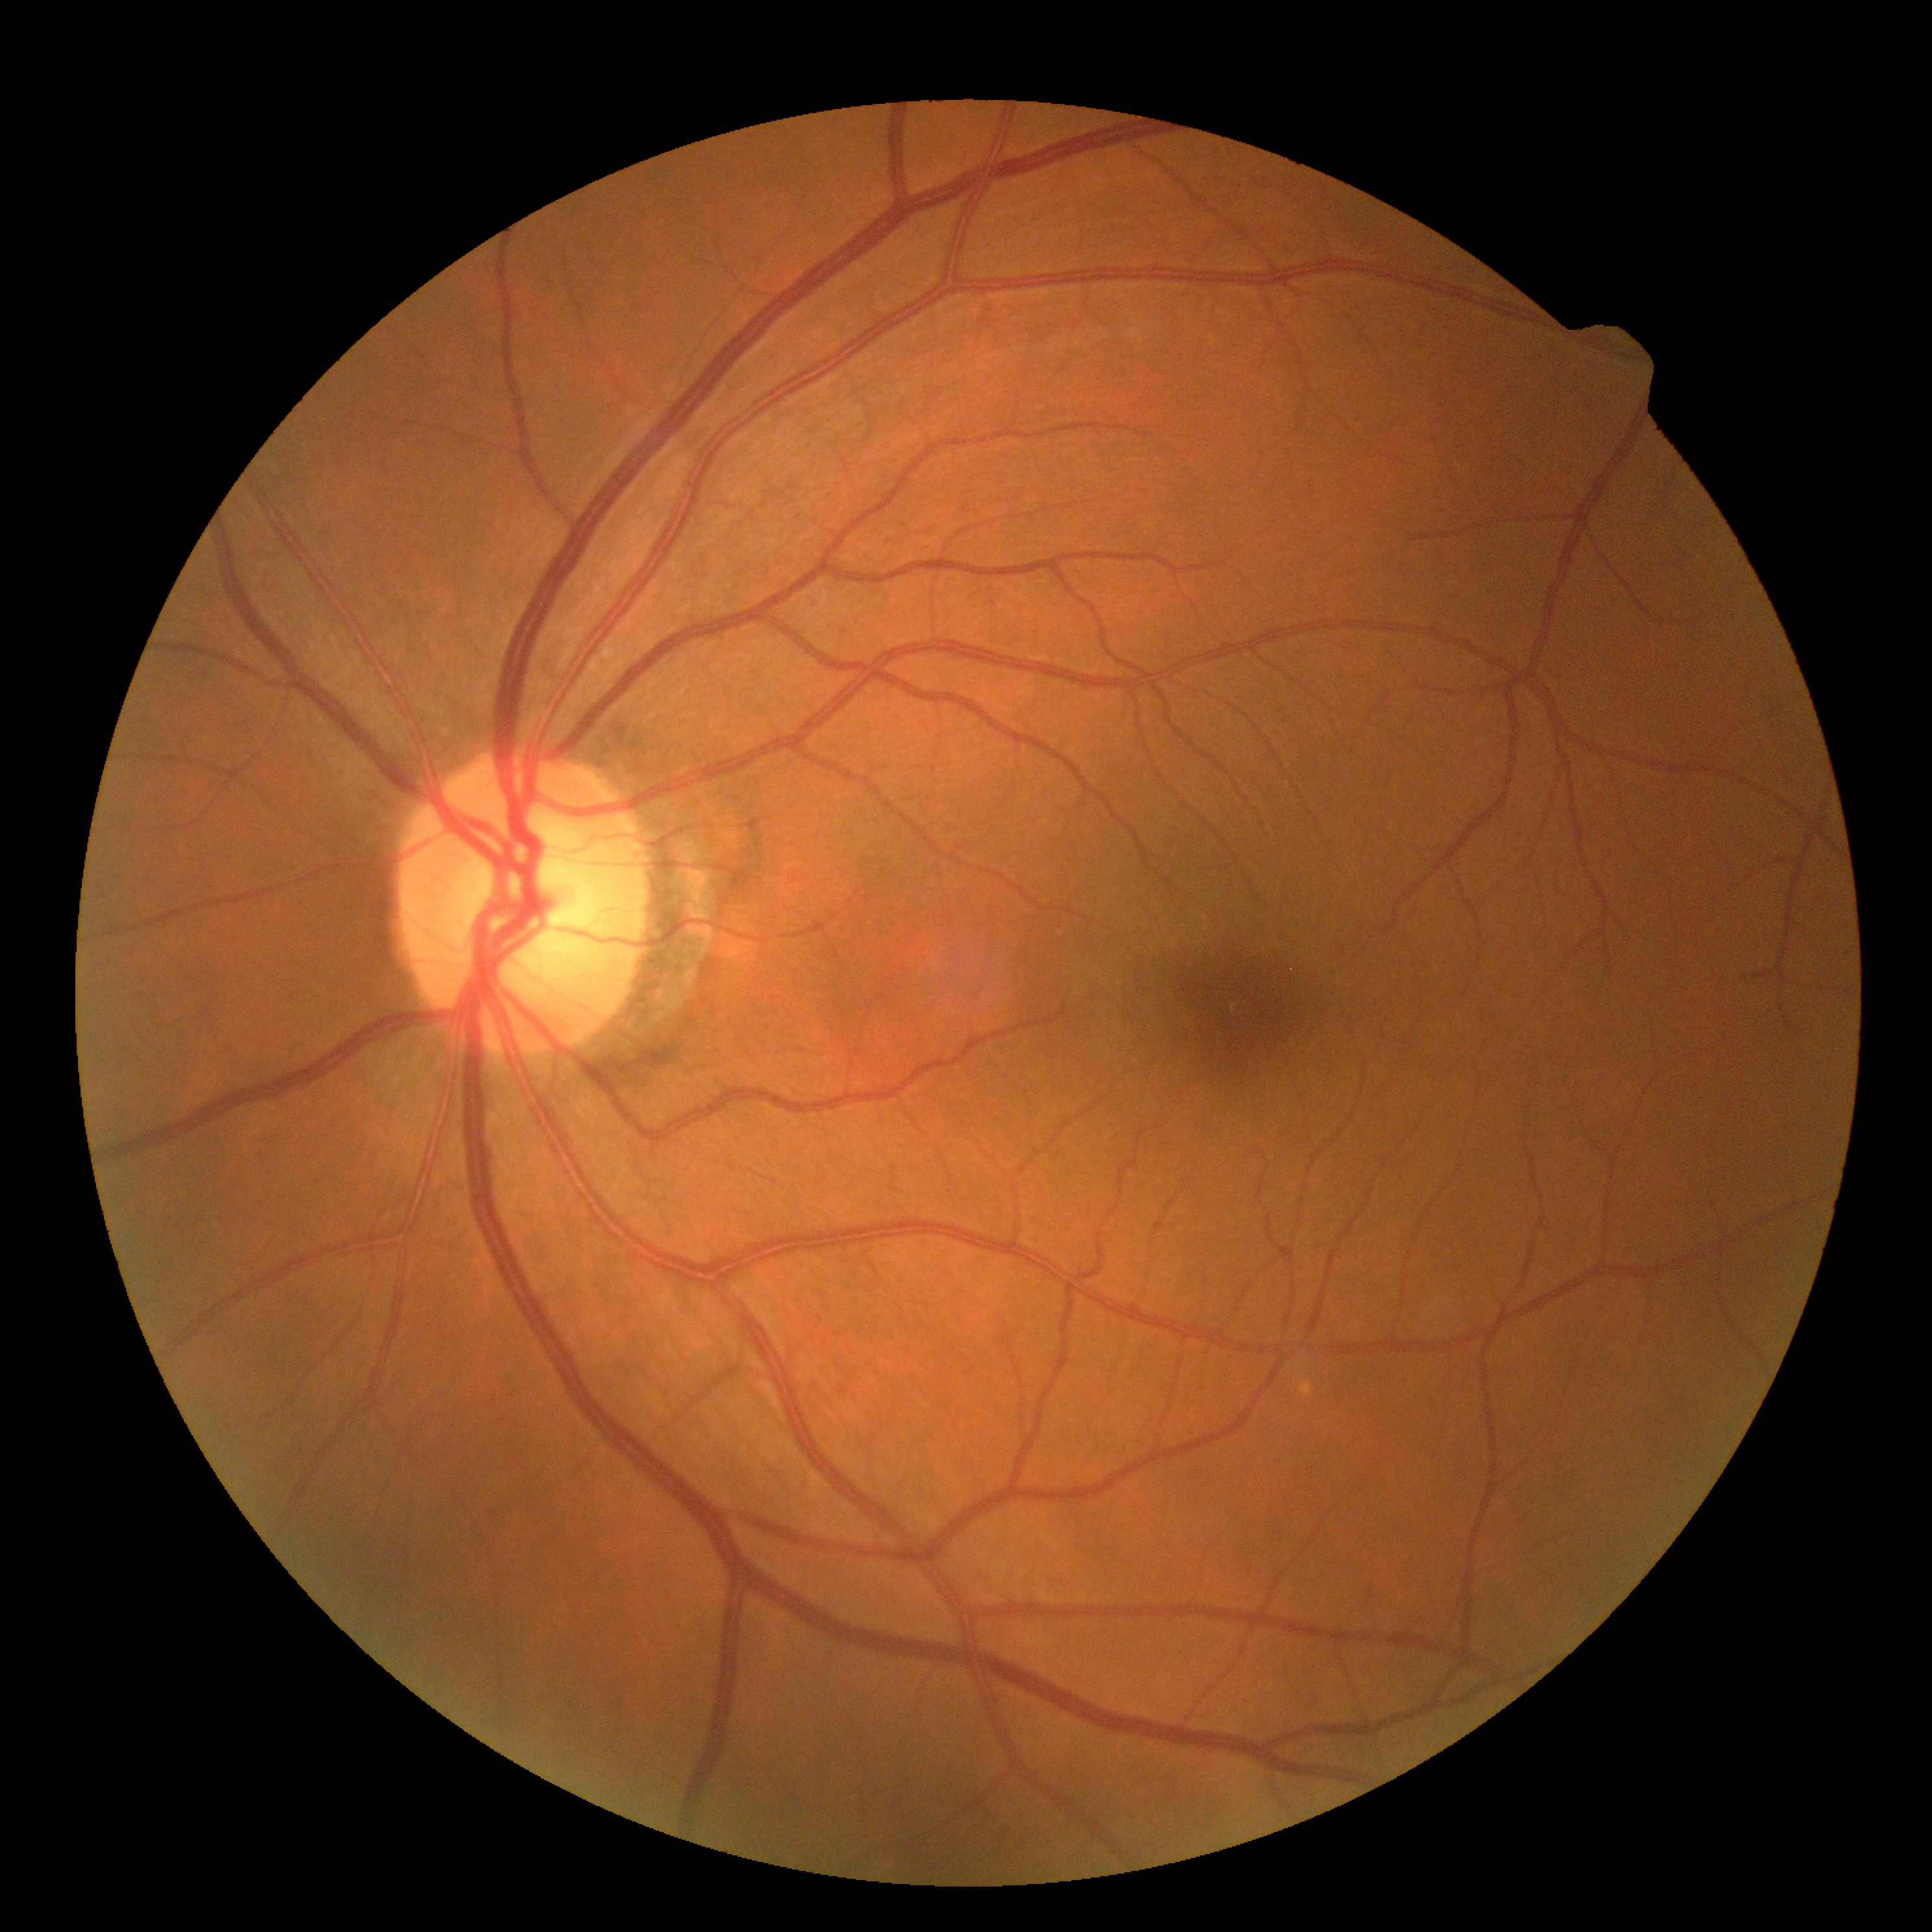
diabetic retinopathy: 0/4.